Image size 1920x1440:
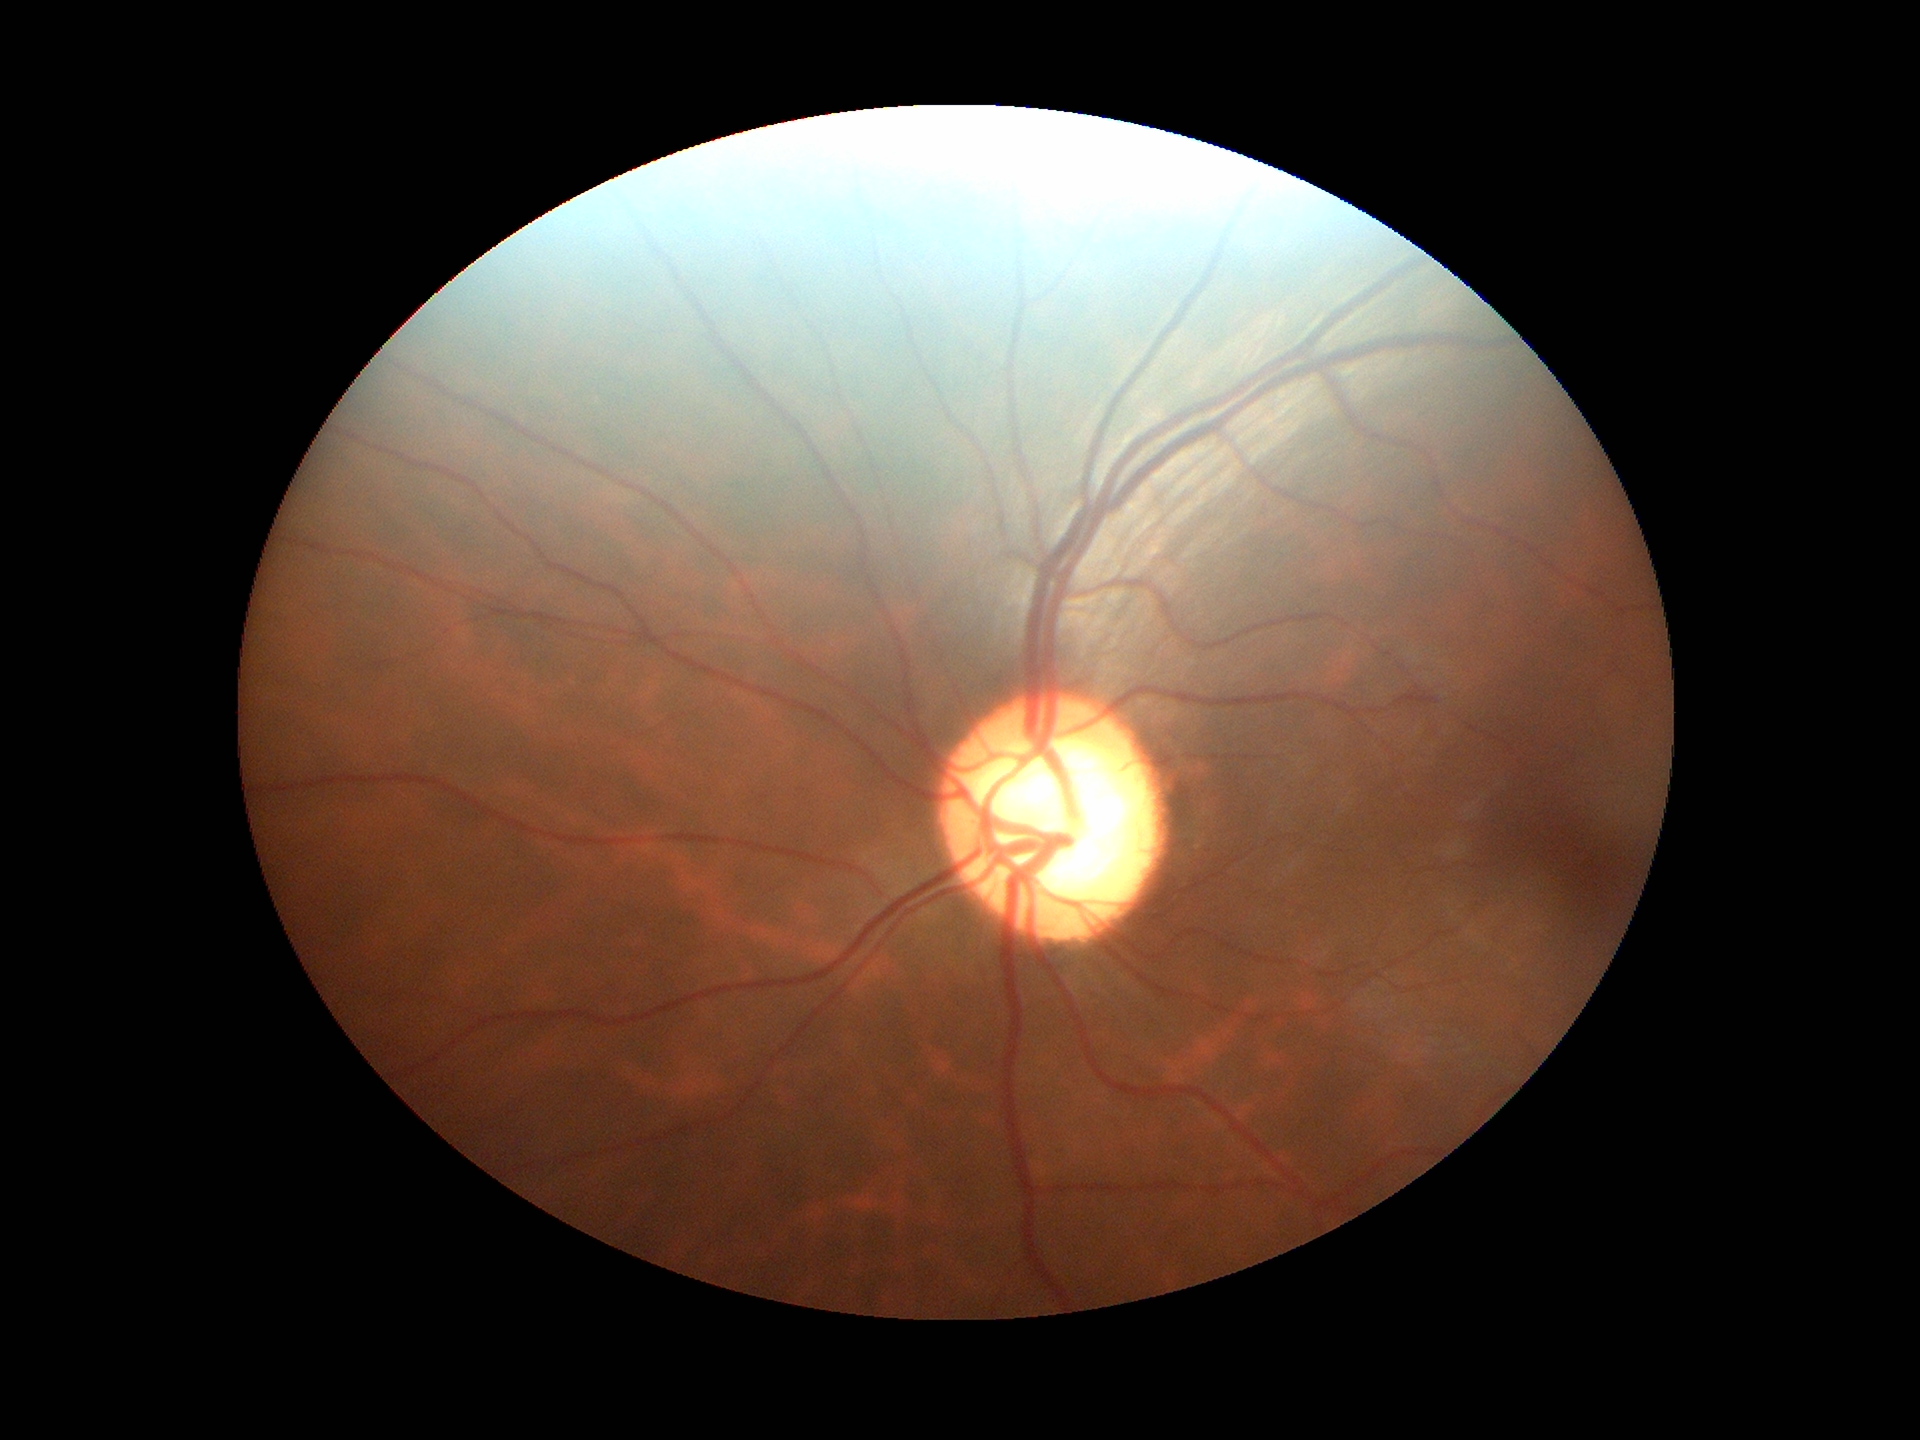

• Glaucoma impression — suspicious findings
• VCDR — 0.67
• HCDR — 0.69